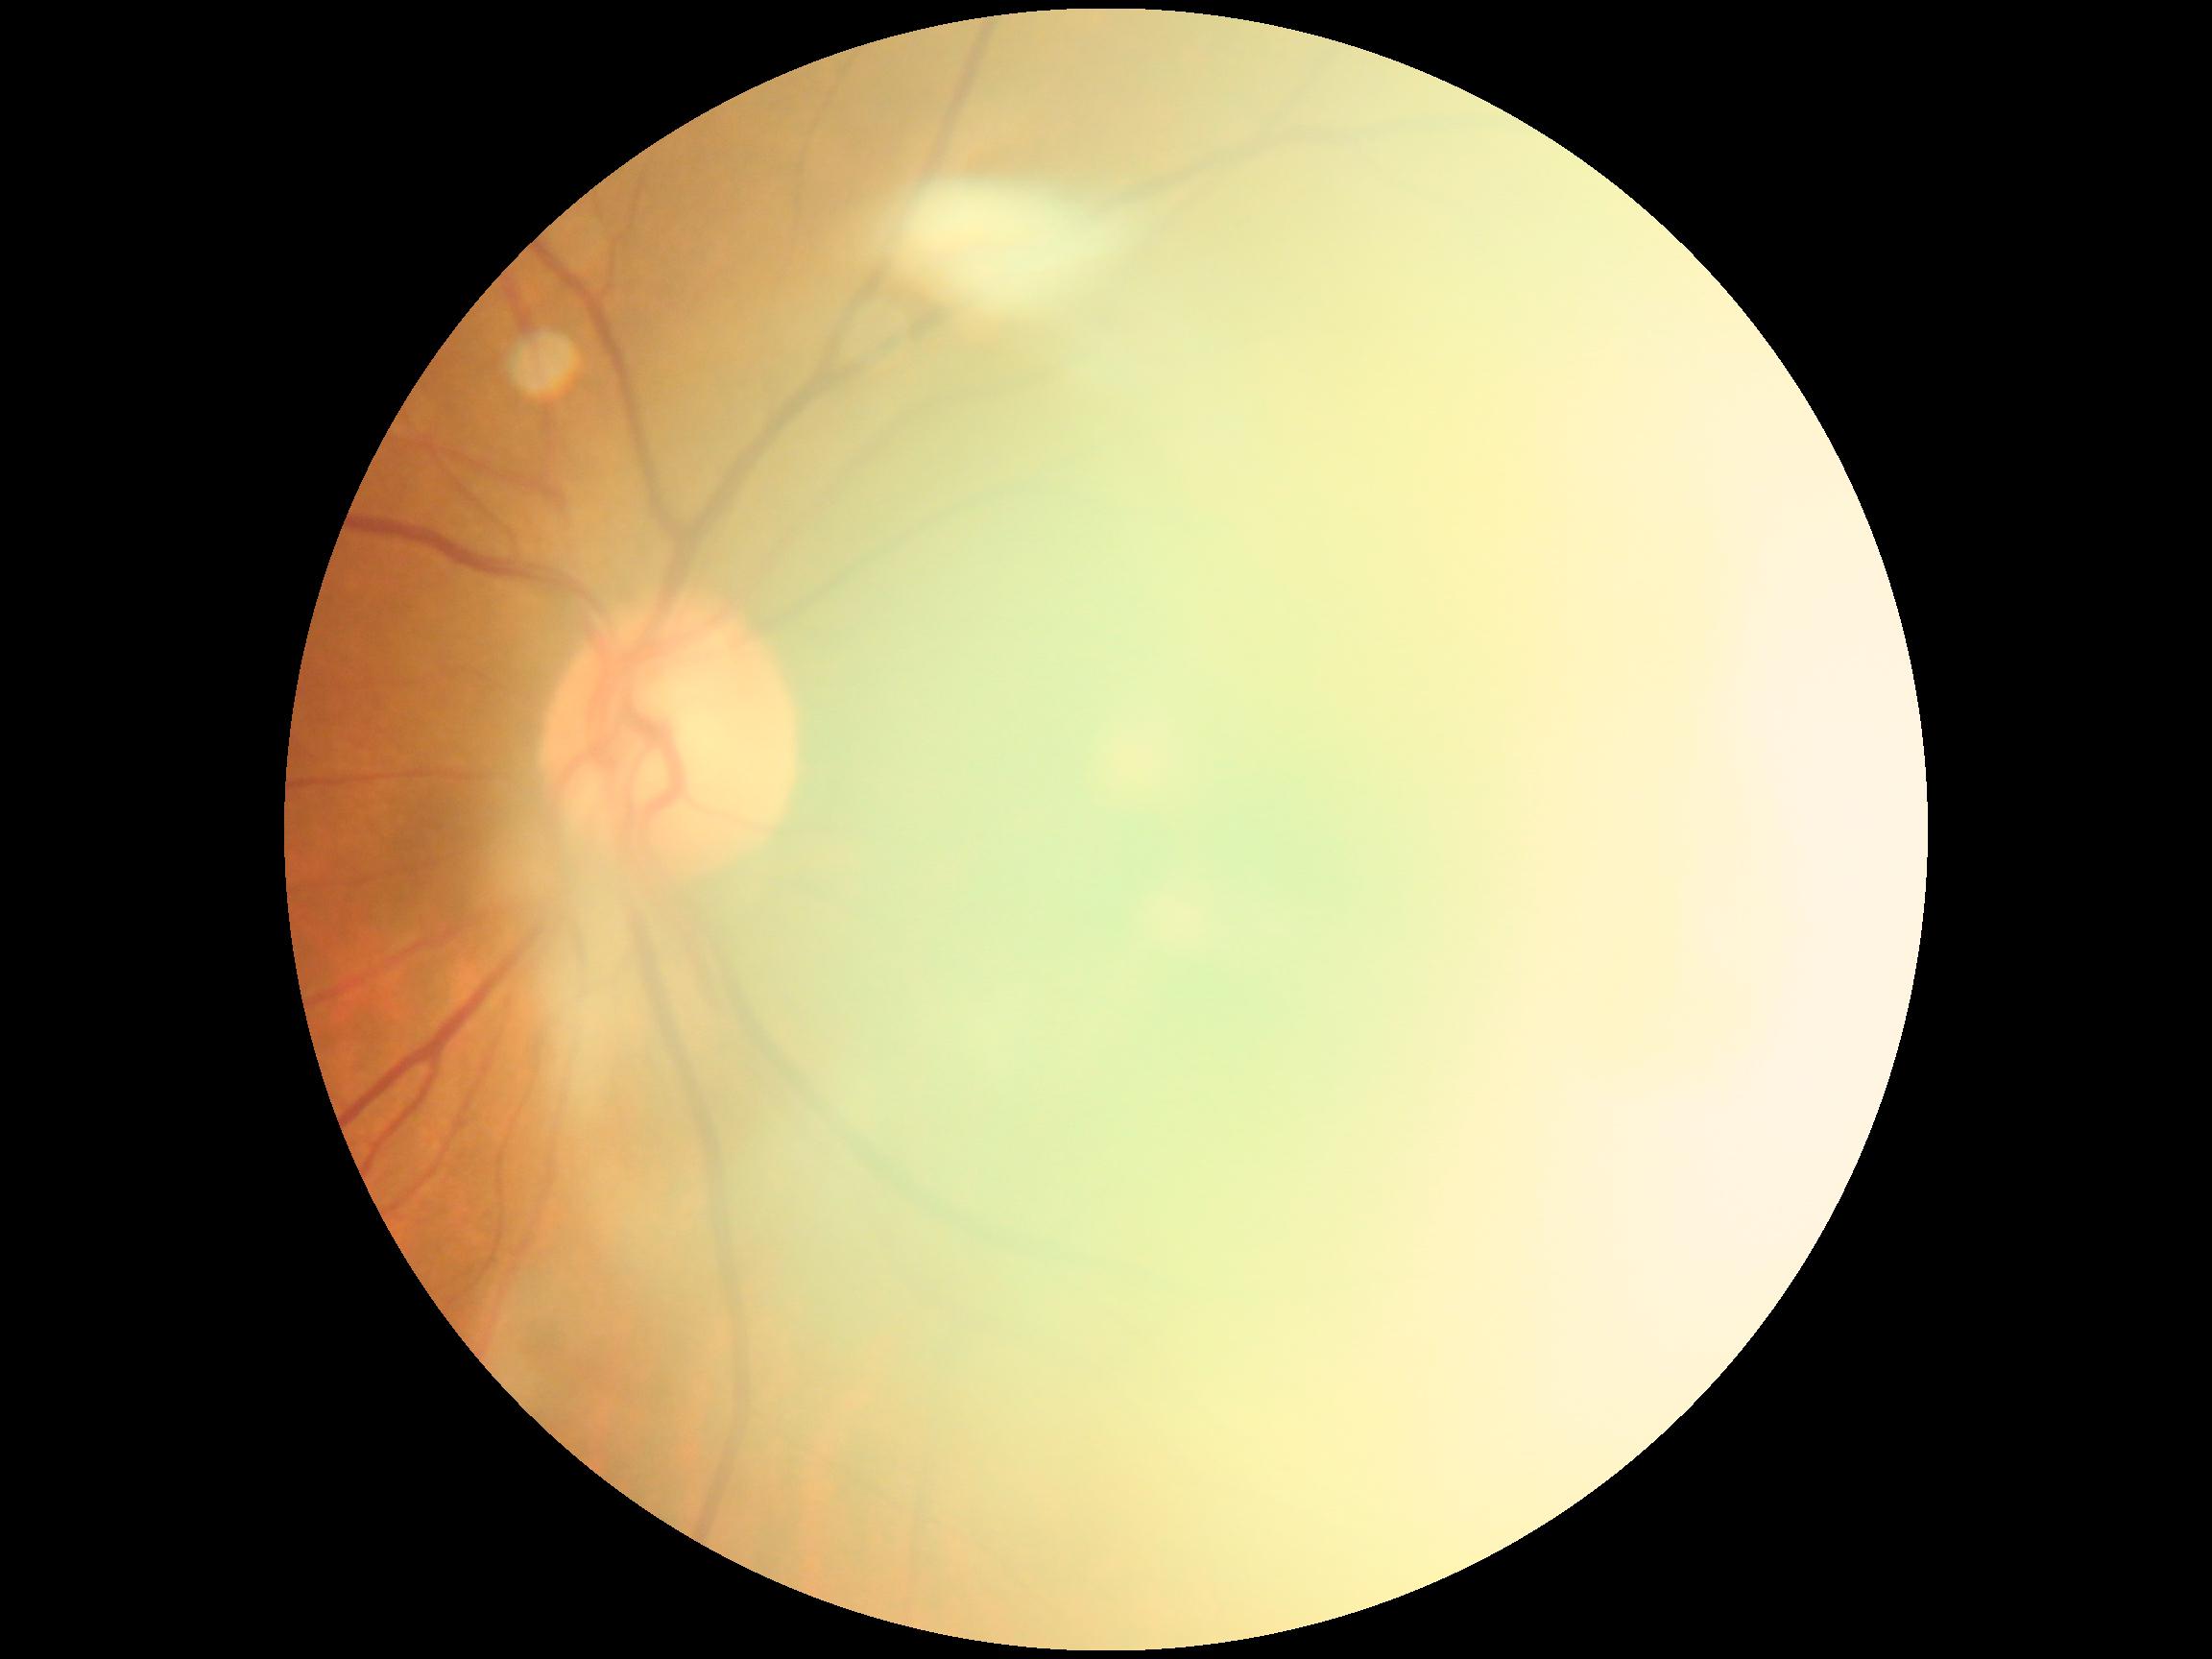
Quality too poor to assess for DR.
DR is ungradable.